45° FOV · fundus photo · image size 2346x1568.
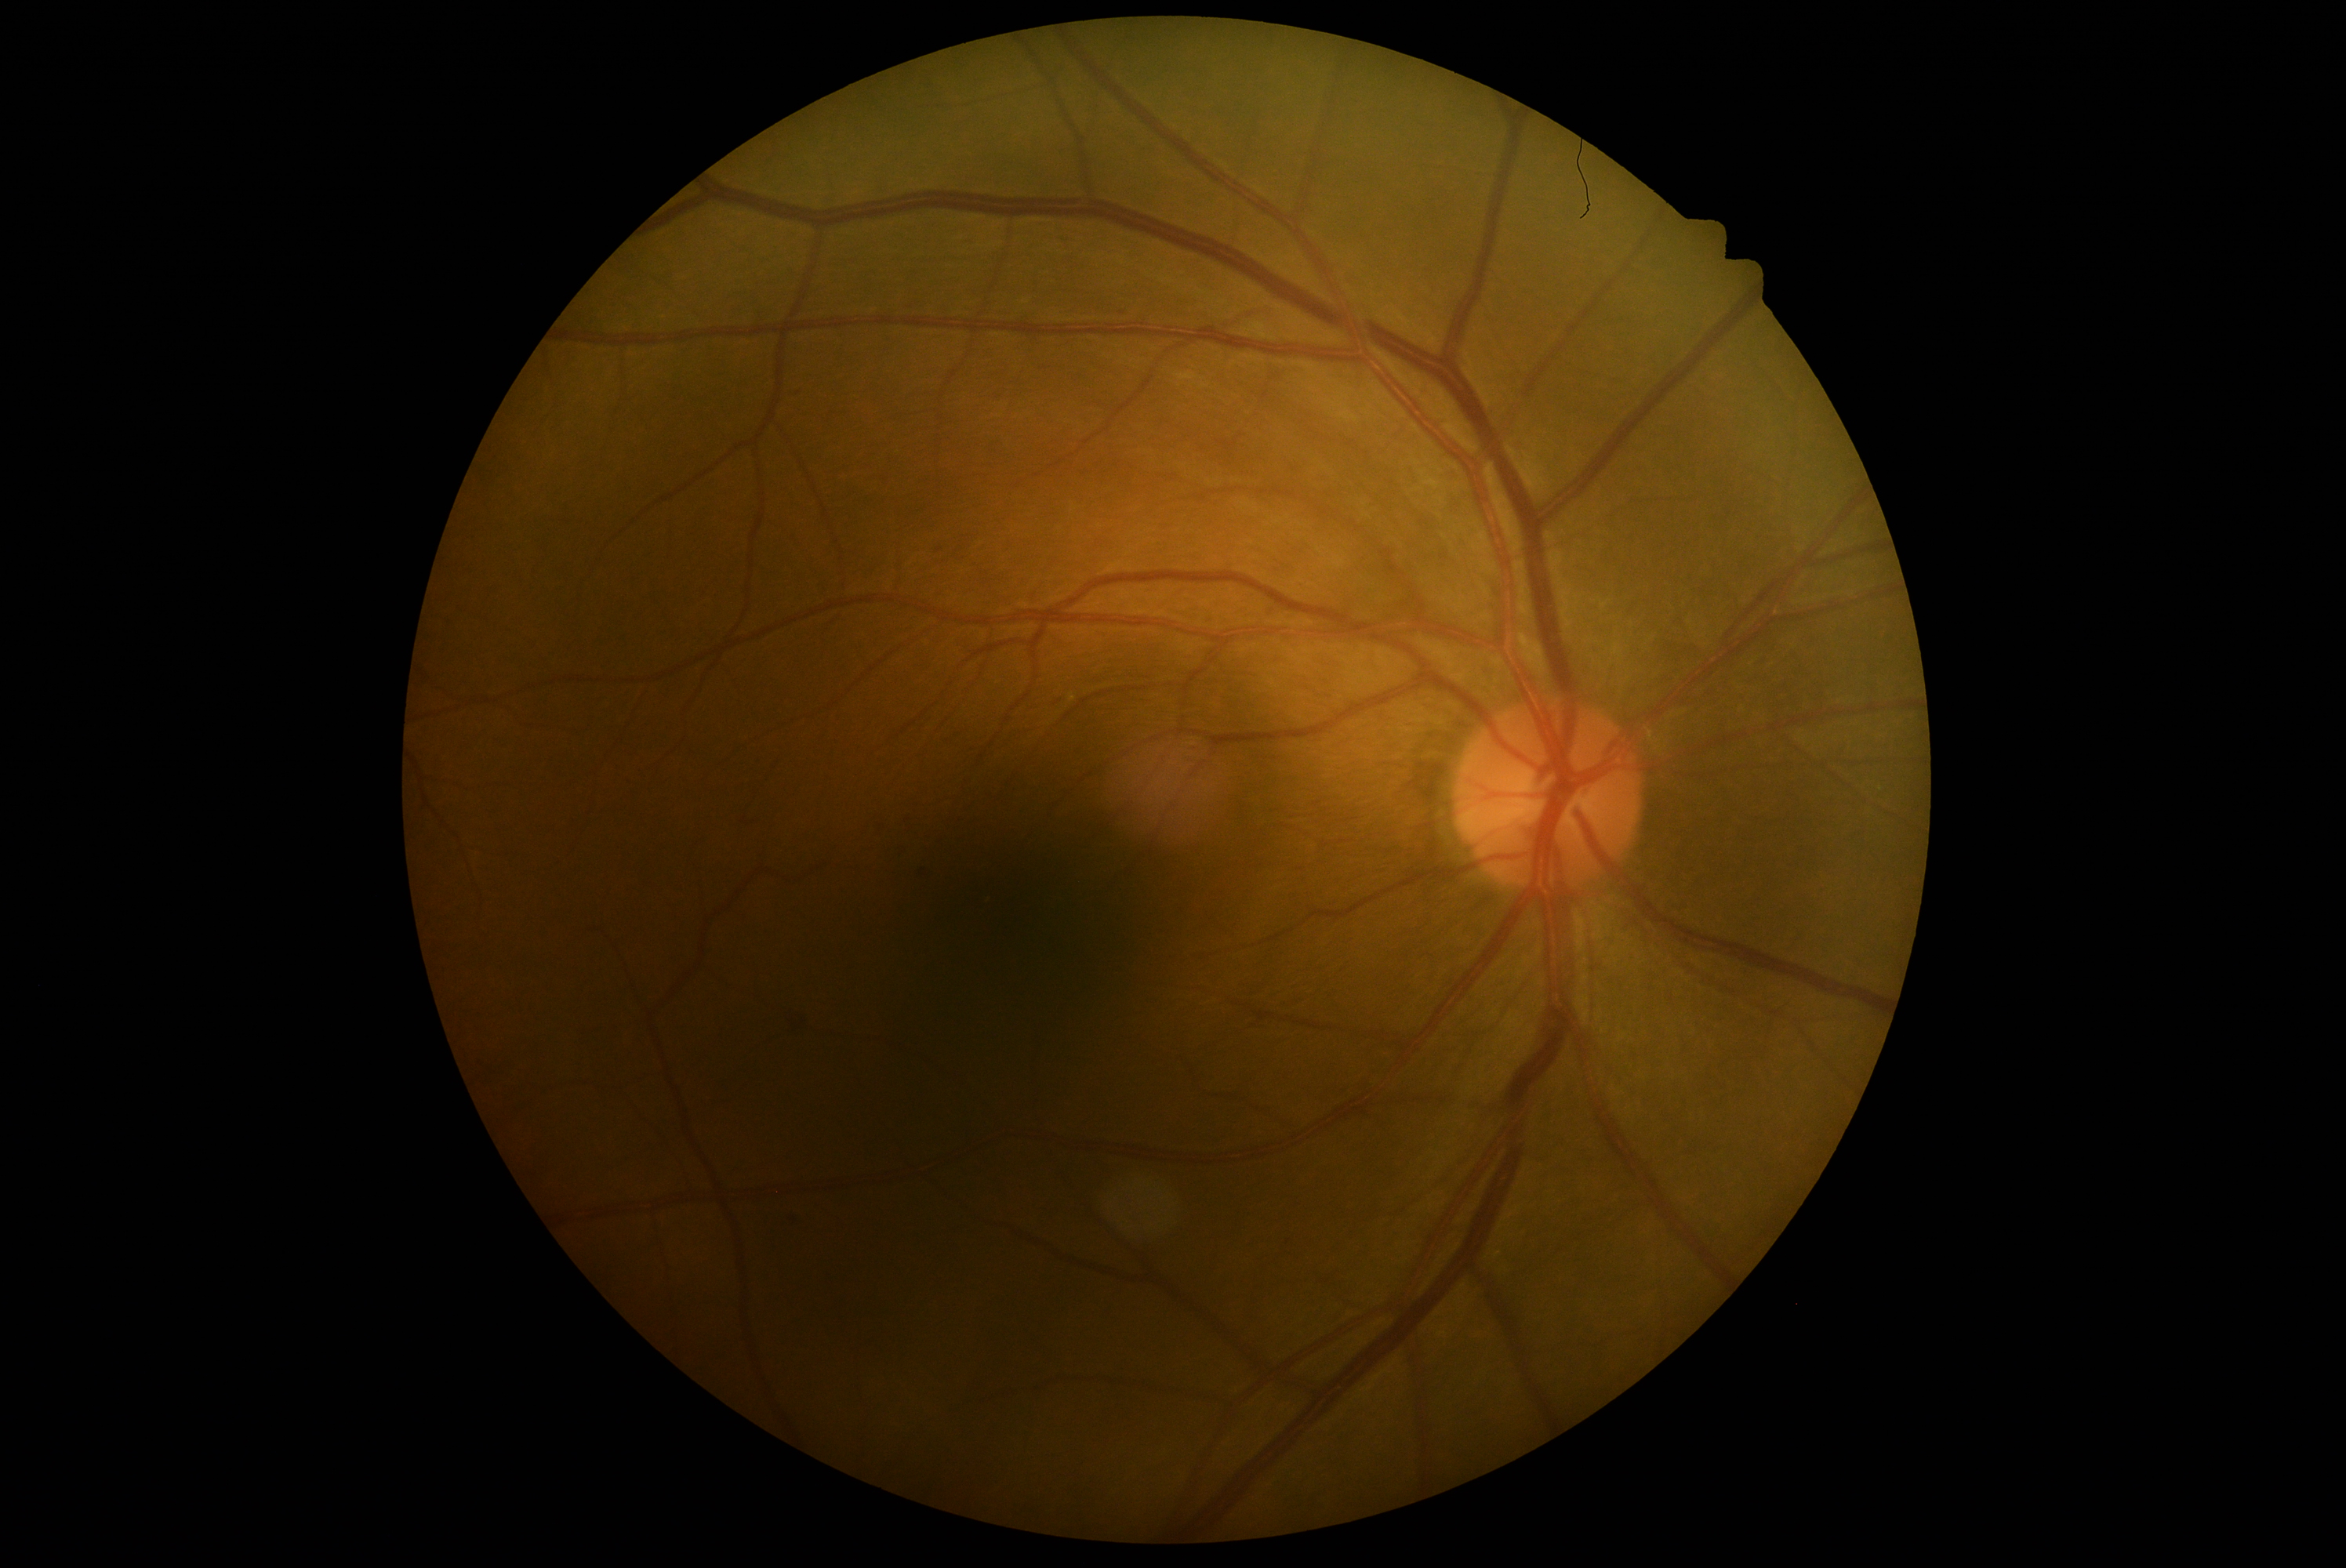

DR severity: 2 — more than just microaneurysms but less than severe NPDR.